RetCam wide-field infant fundus image
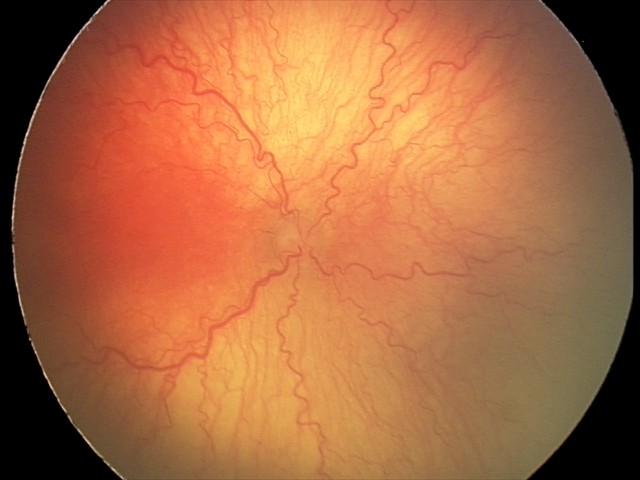

Screening diagnosis: plus disease — abnormal dilation and tortuosity of the posterior pole retinal vessels | aggressive ROP (A-ROP).